Modified Davis classification — 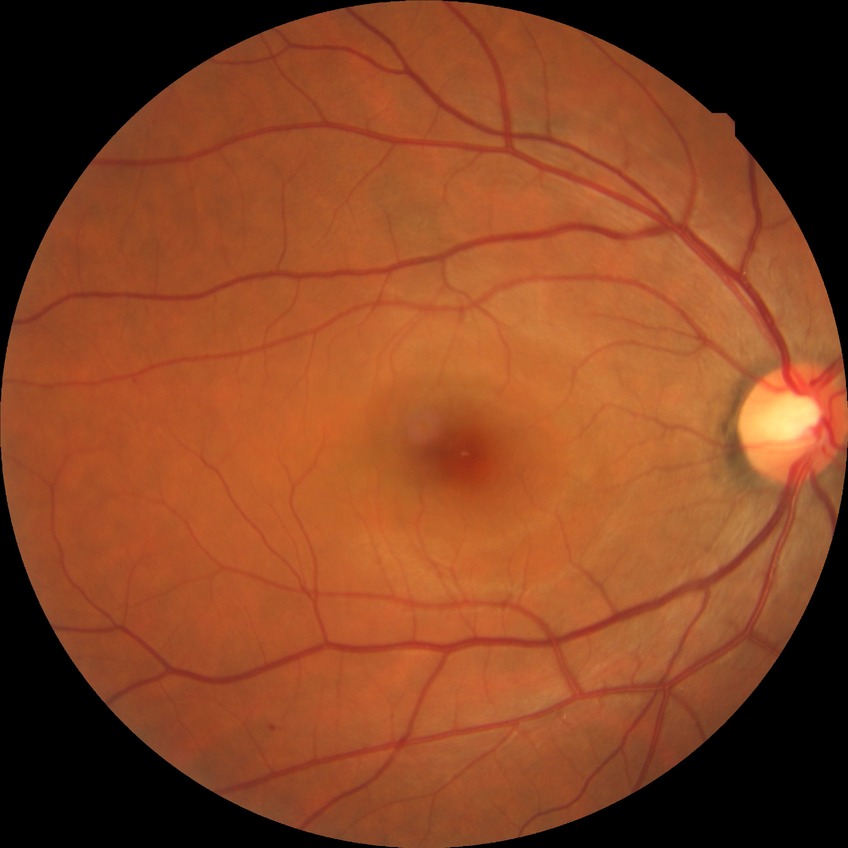 The retinopathy is classified as non-proliferative diabetic retinopathy. Diabetic retinopathy (DR) is simple diabetic retinopathy (SDR).